848x848px:
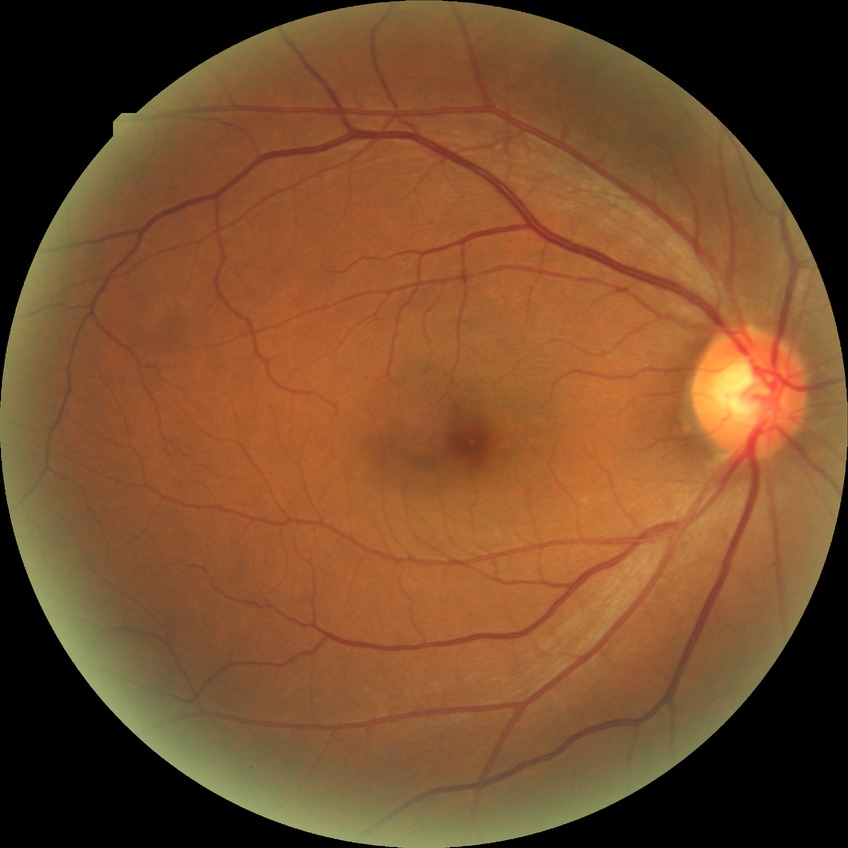

– diabetic retinopathy (DR): simple diabetic retinopathy (SDR)